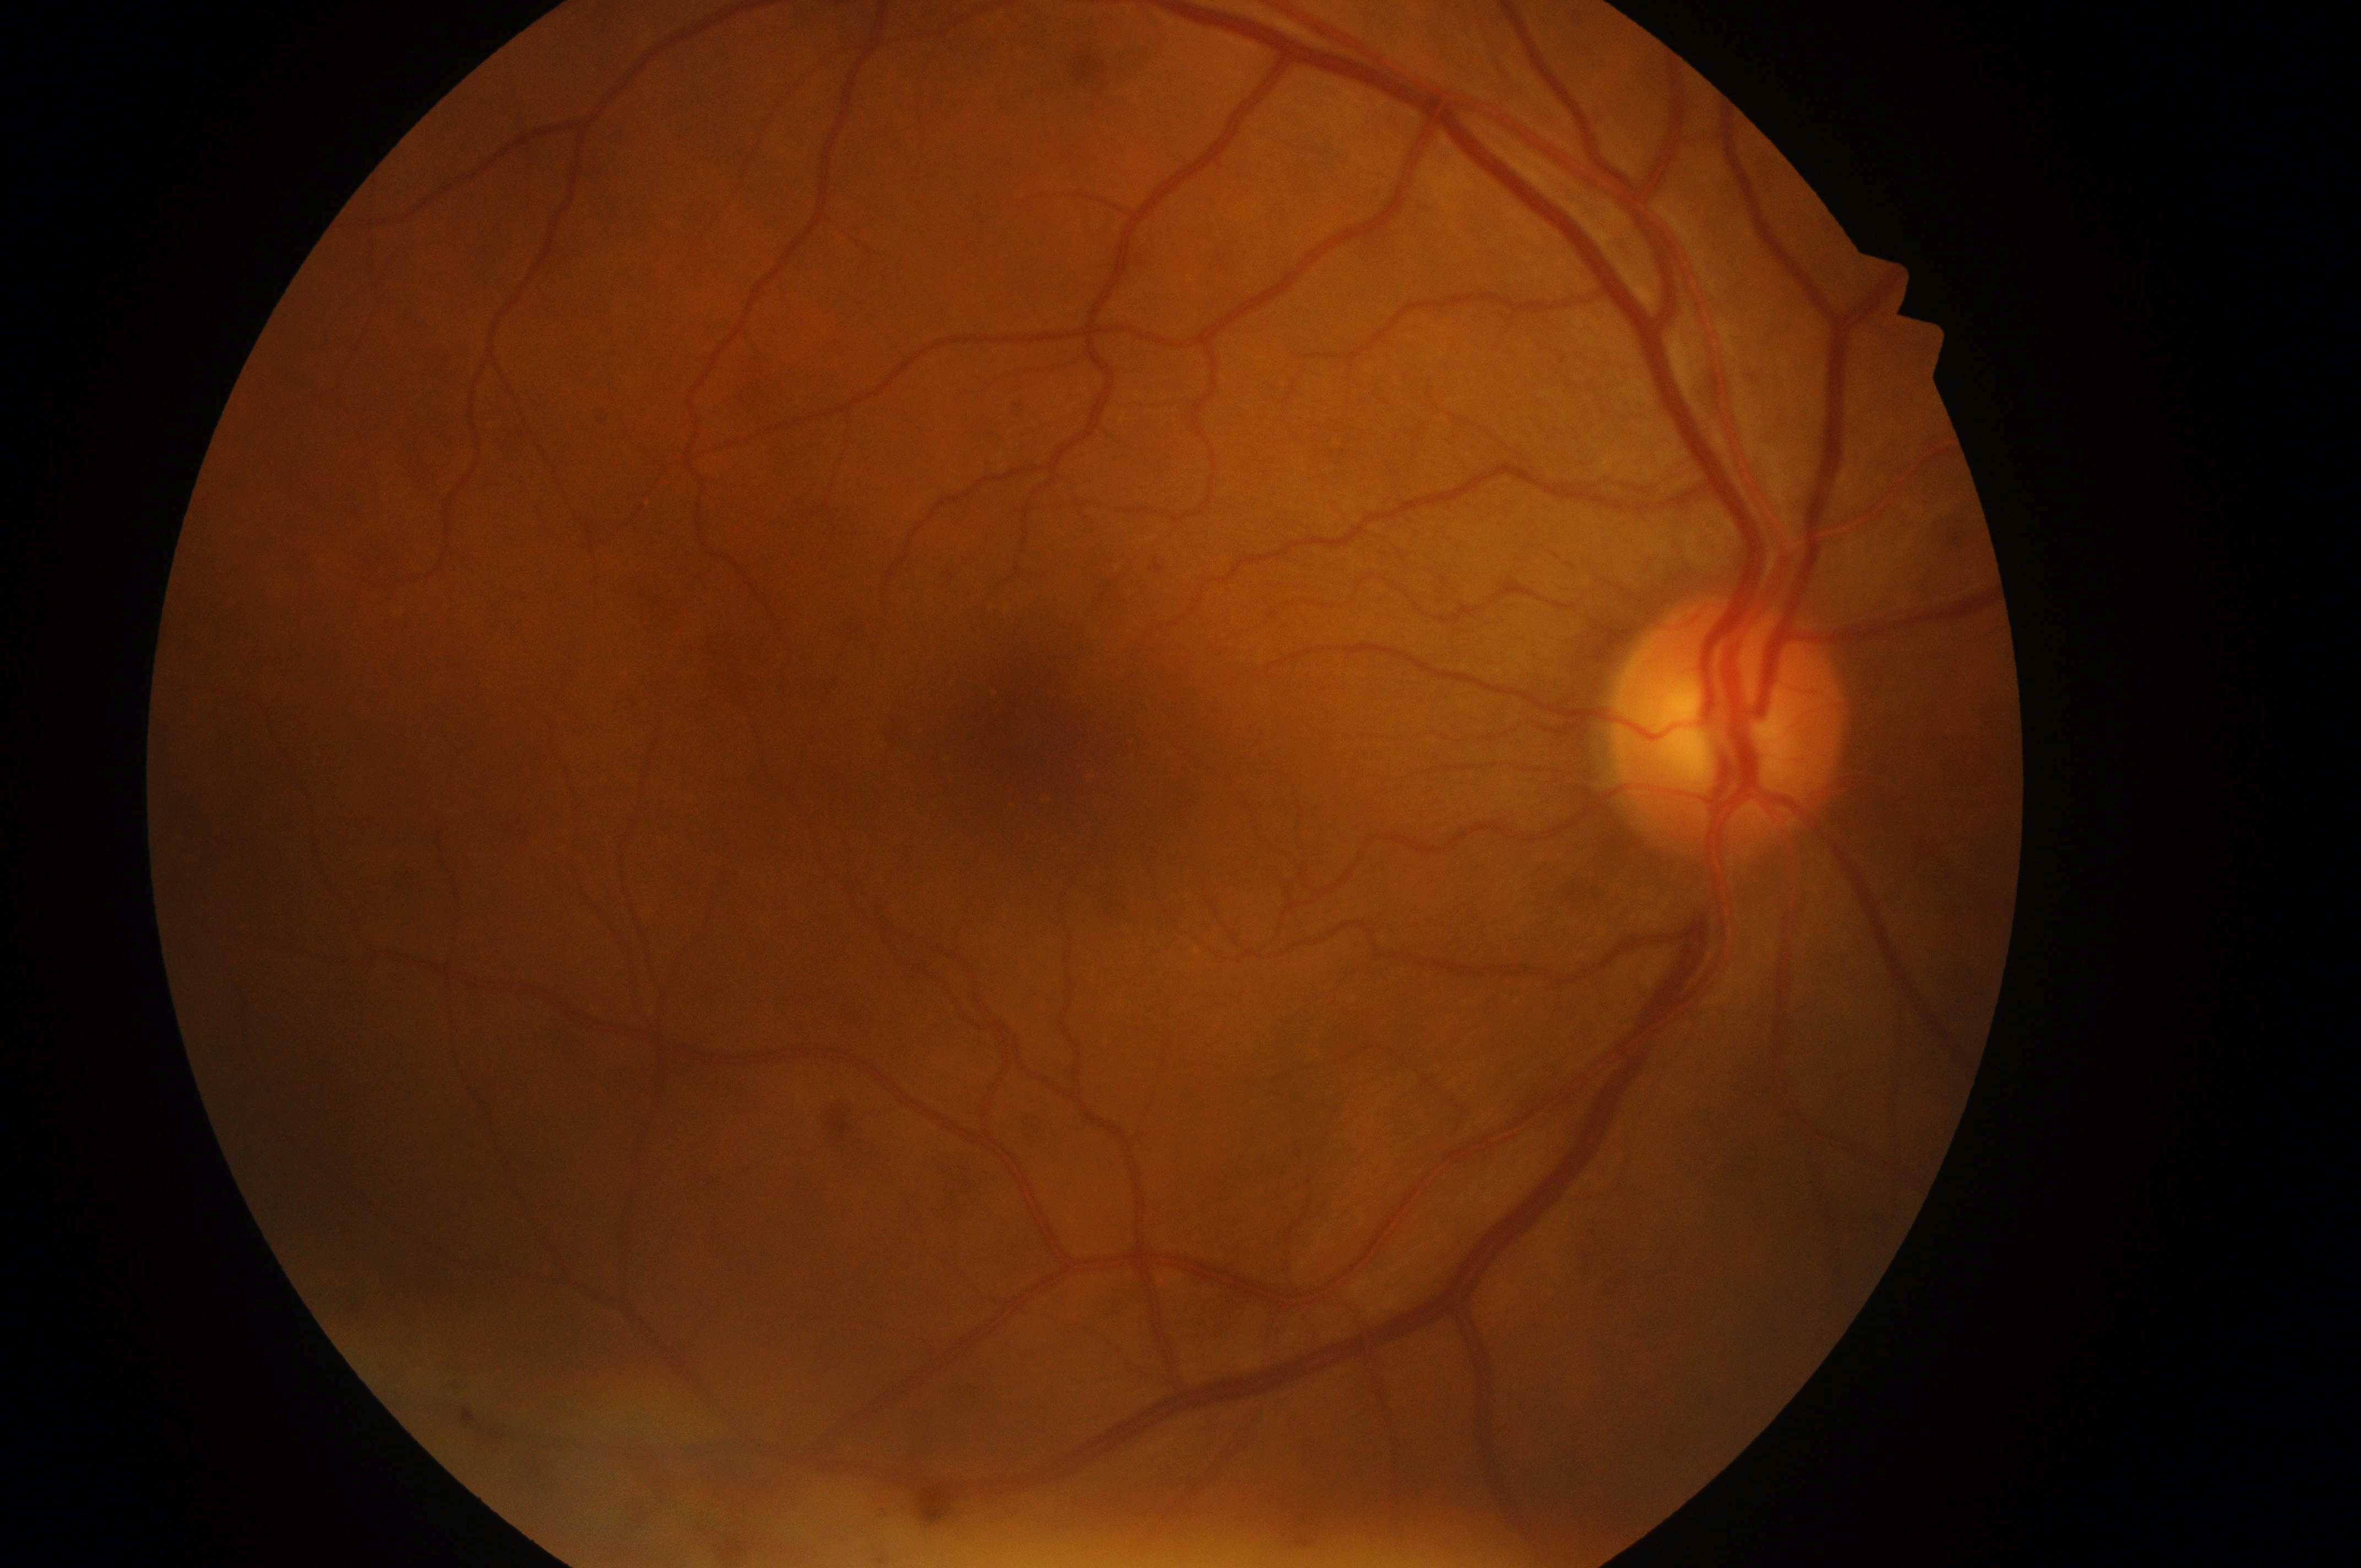 DR grade is no apparent retinopathy (0) — no visible signs of diabetic retinopathy. The image shows the OD. Fovea centralis: (1037,736). The optic nerve head is at (1724,738). DME risk: no risk (grade 0) — no apparent hard exudates.